45° field of view: 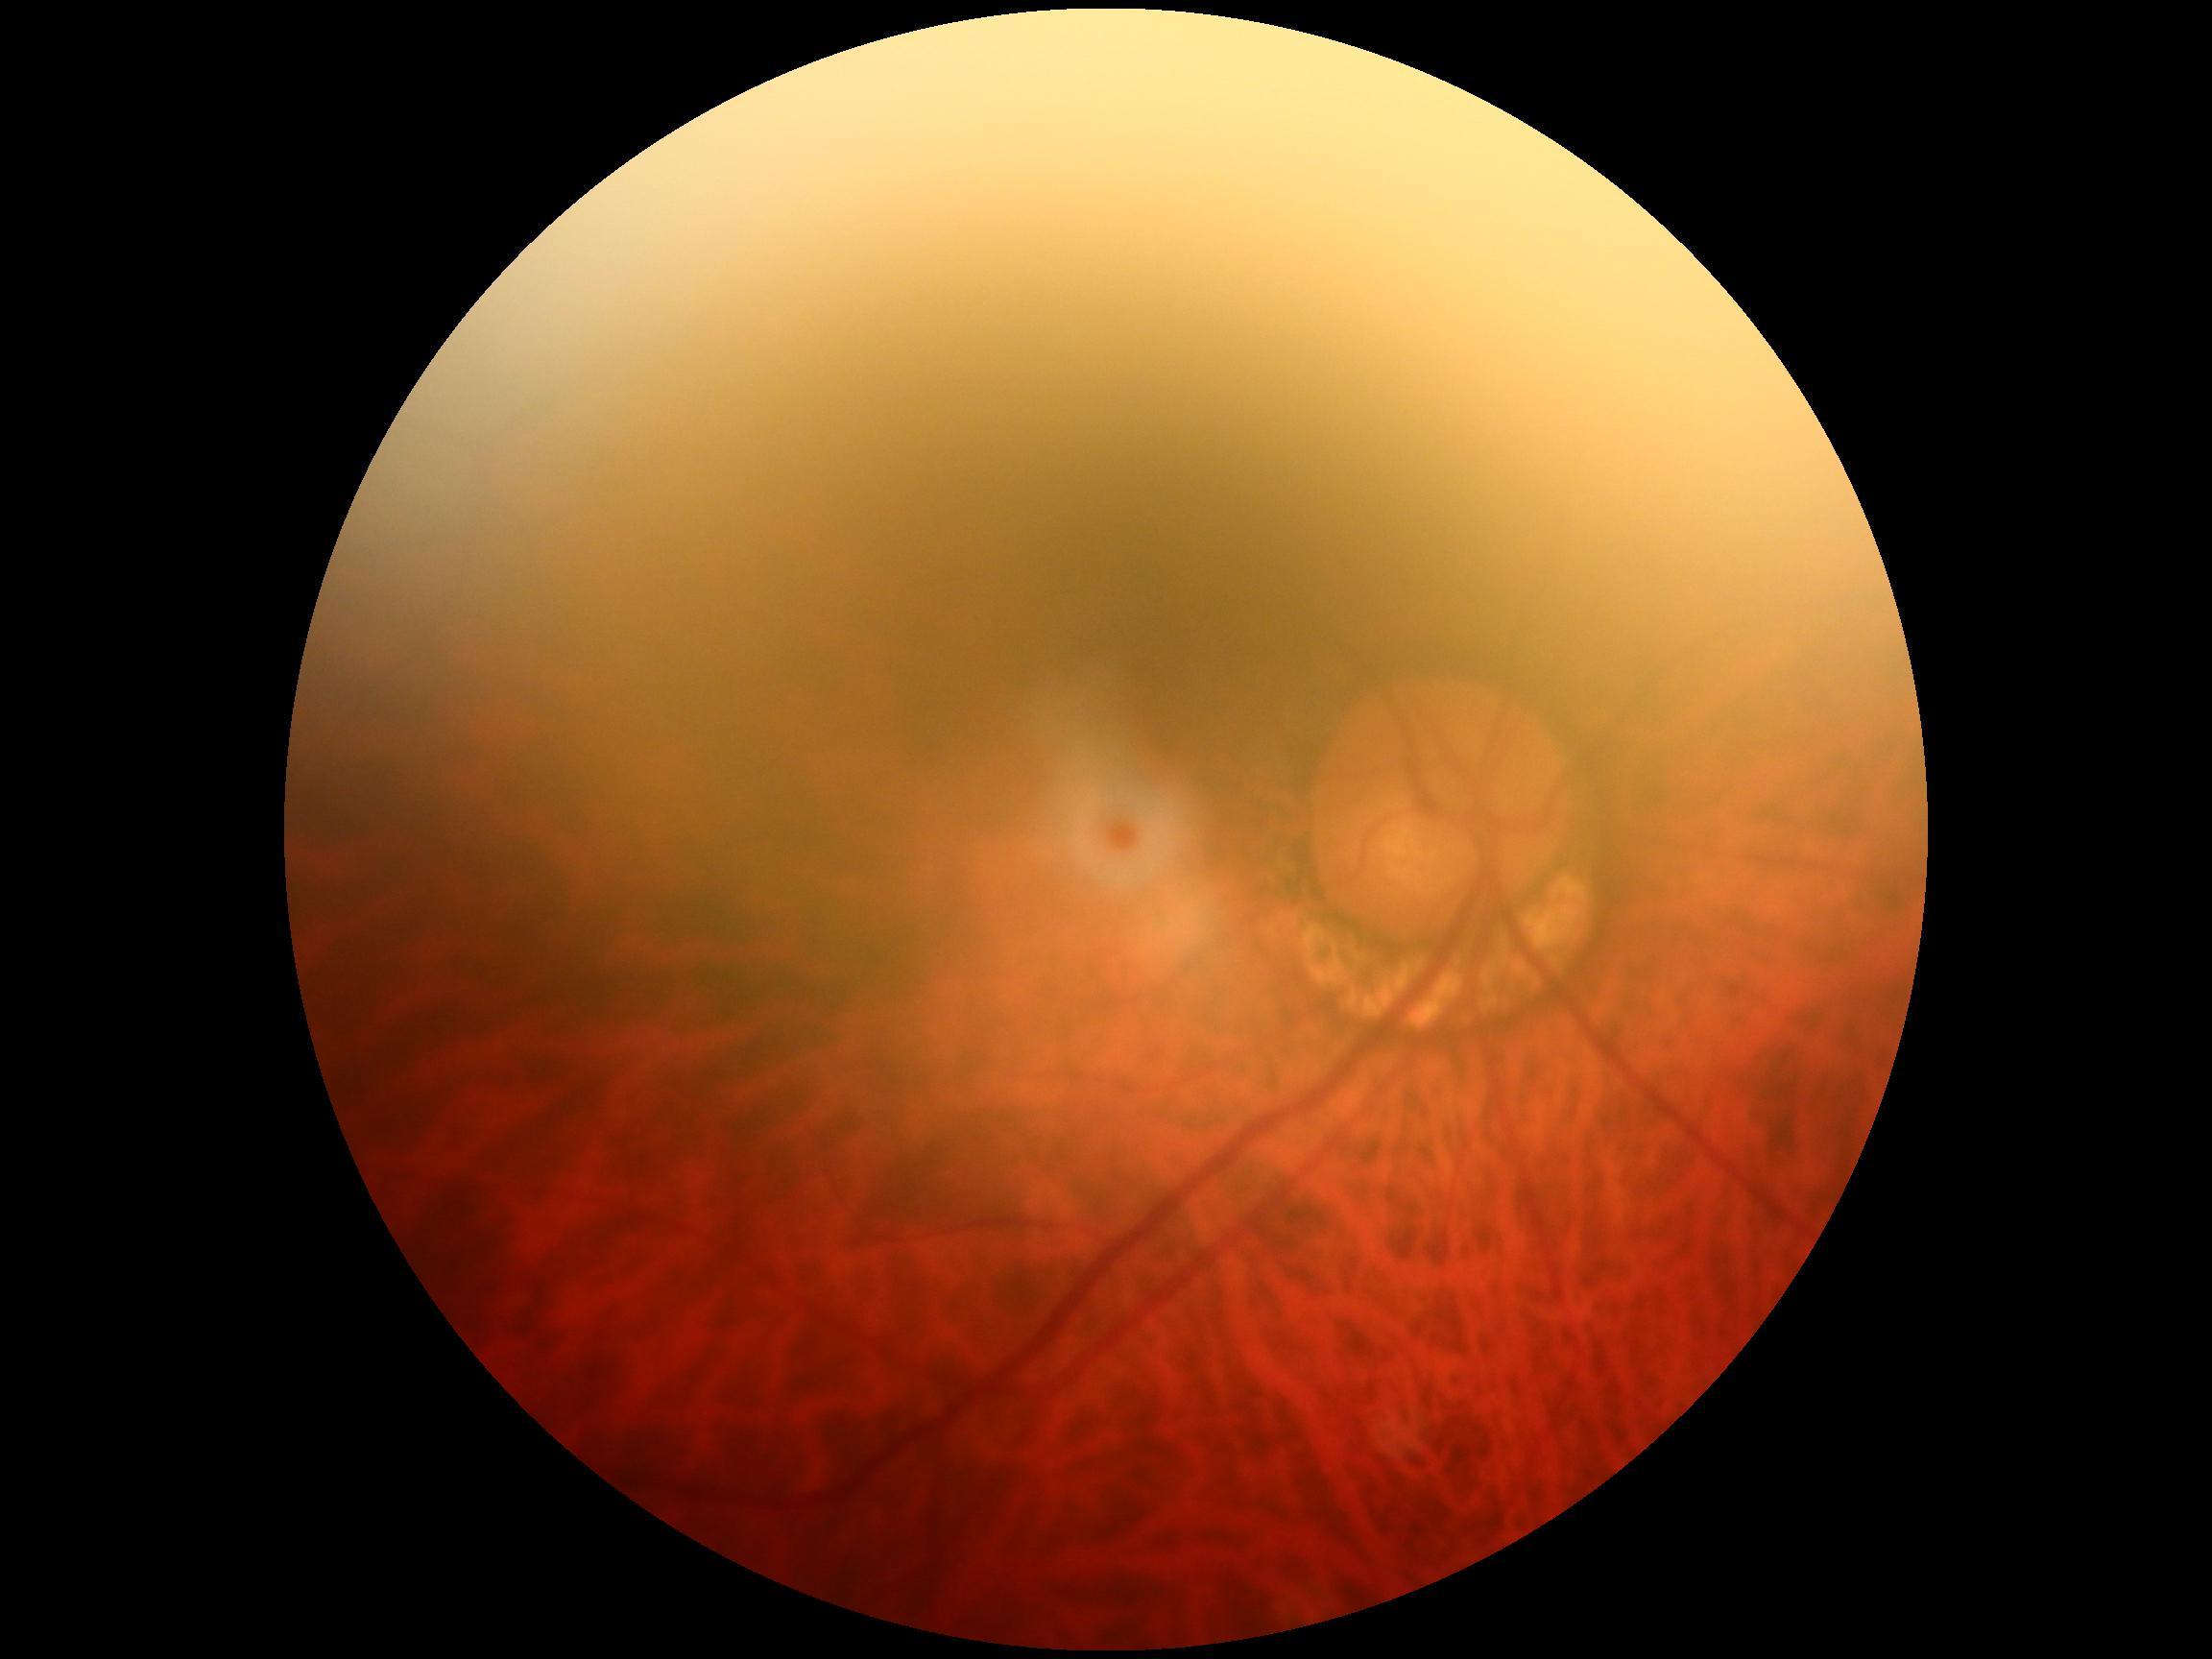

DR grade = 0 (no apparent retinopathy) — no visible signs of diabetic retinopathy.